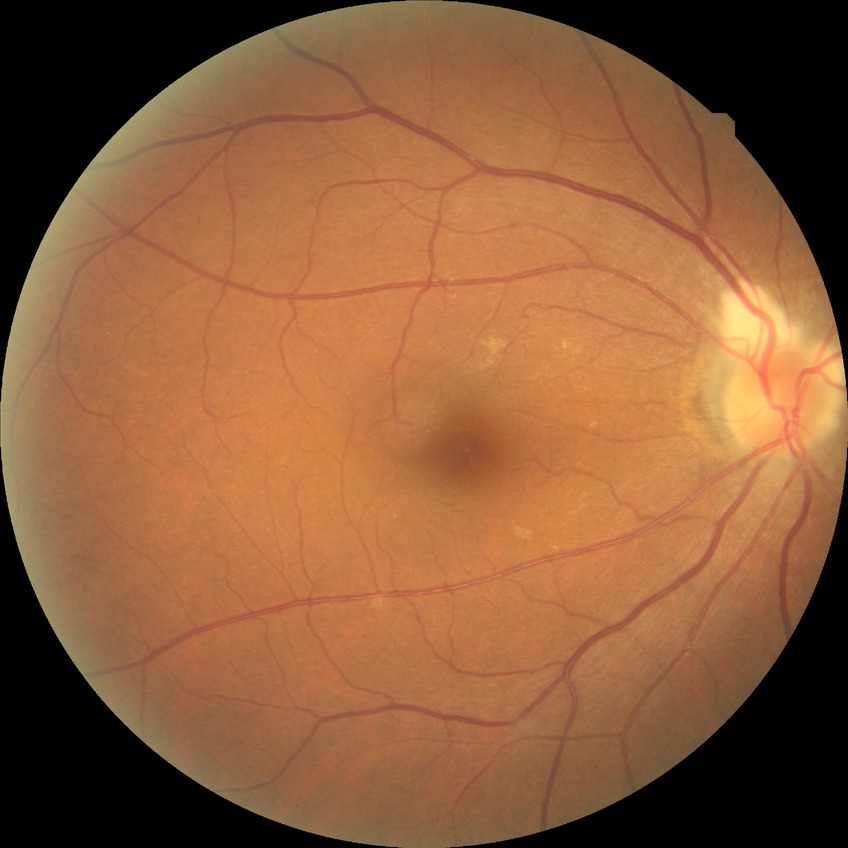 Findings:
– diabetic retinopathy (DR): NDR (no diabetic retinopathy)